Color fundus image.
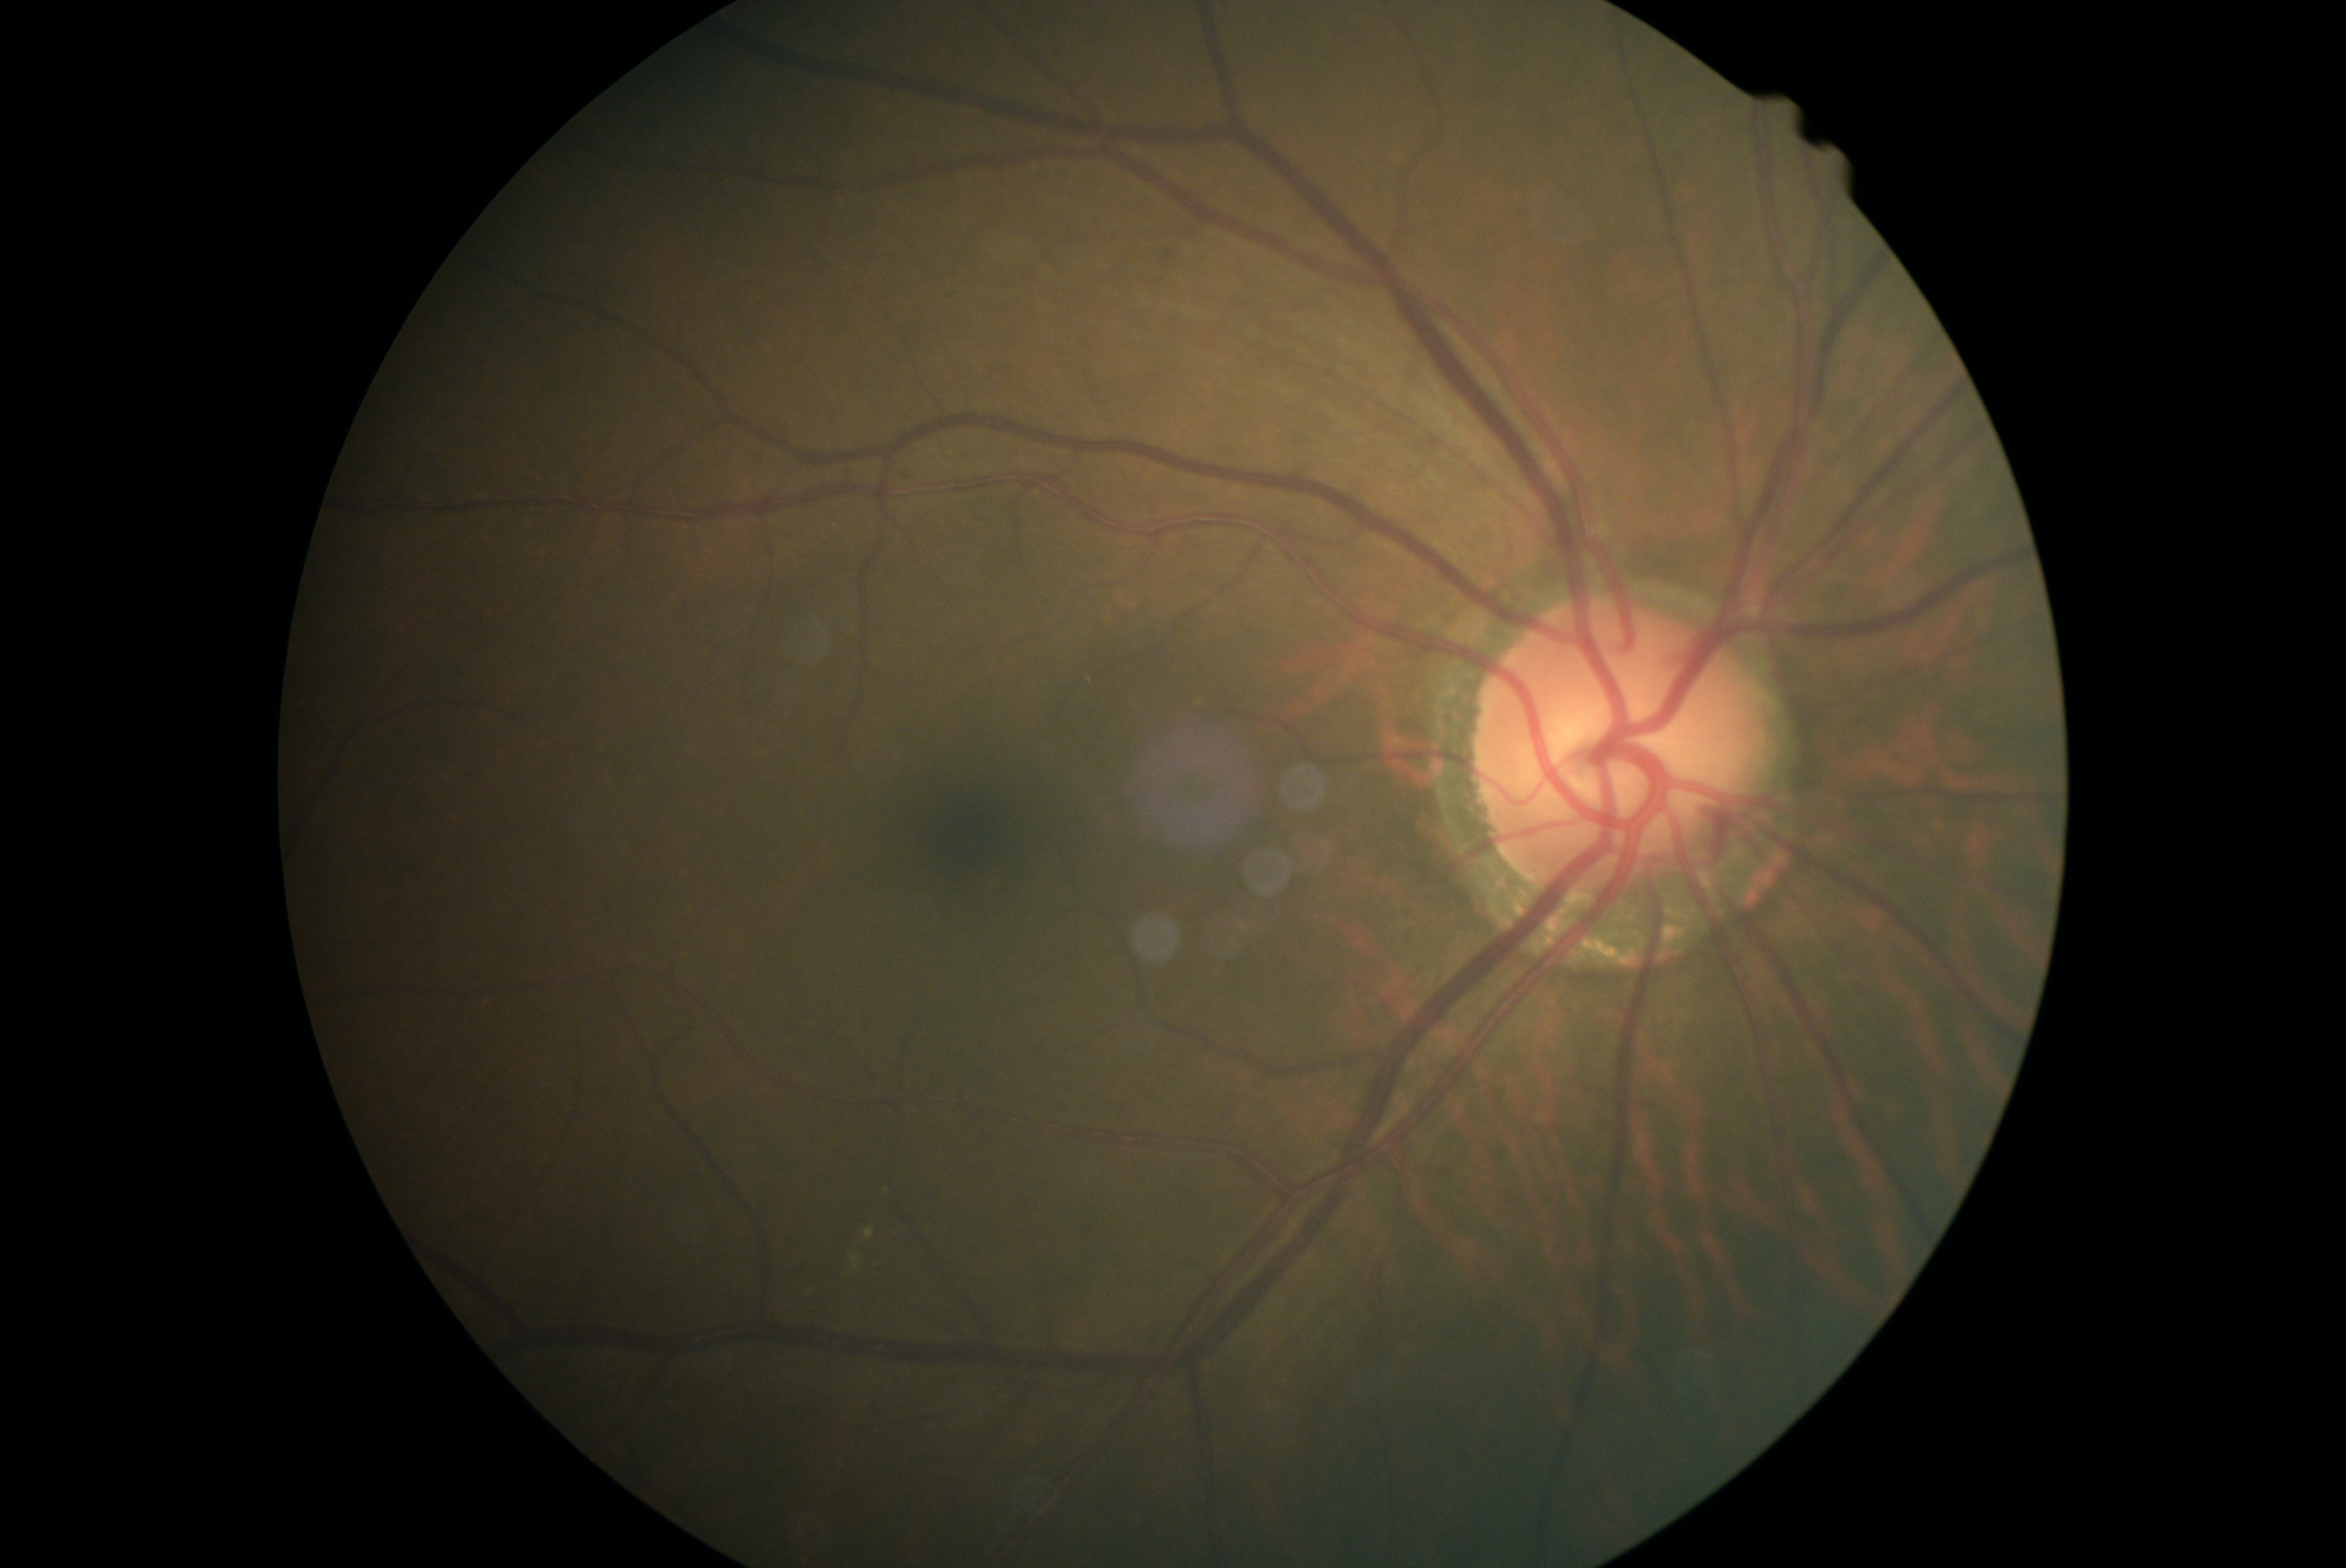 DR stage: moderate non-proliferative diabetic retinopathy (grade 2). DR class: non-proliferative diabetic retinopathy.